Disc-centered fundus crop; FOV 35° before cropping: 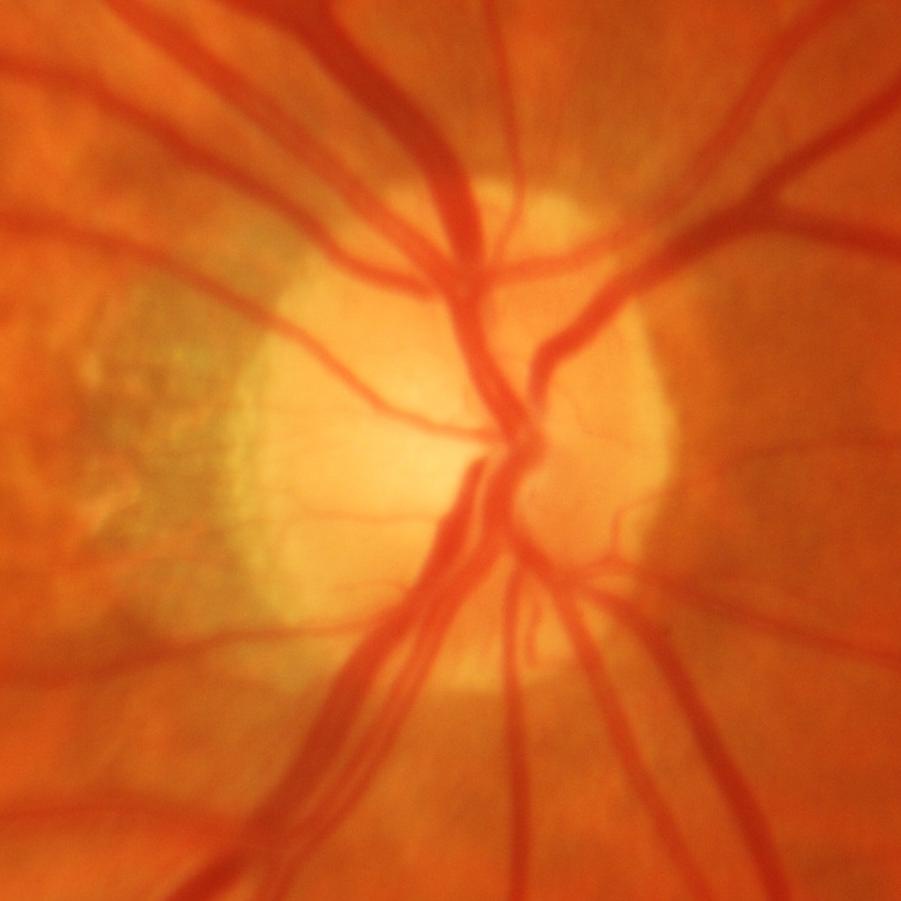 Diagnosis: glaucomatous optic neuropathy.